CFP. 2212x1659. 45° FOV
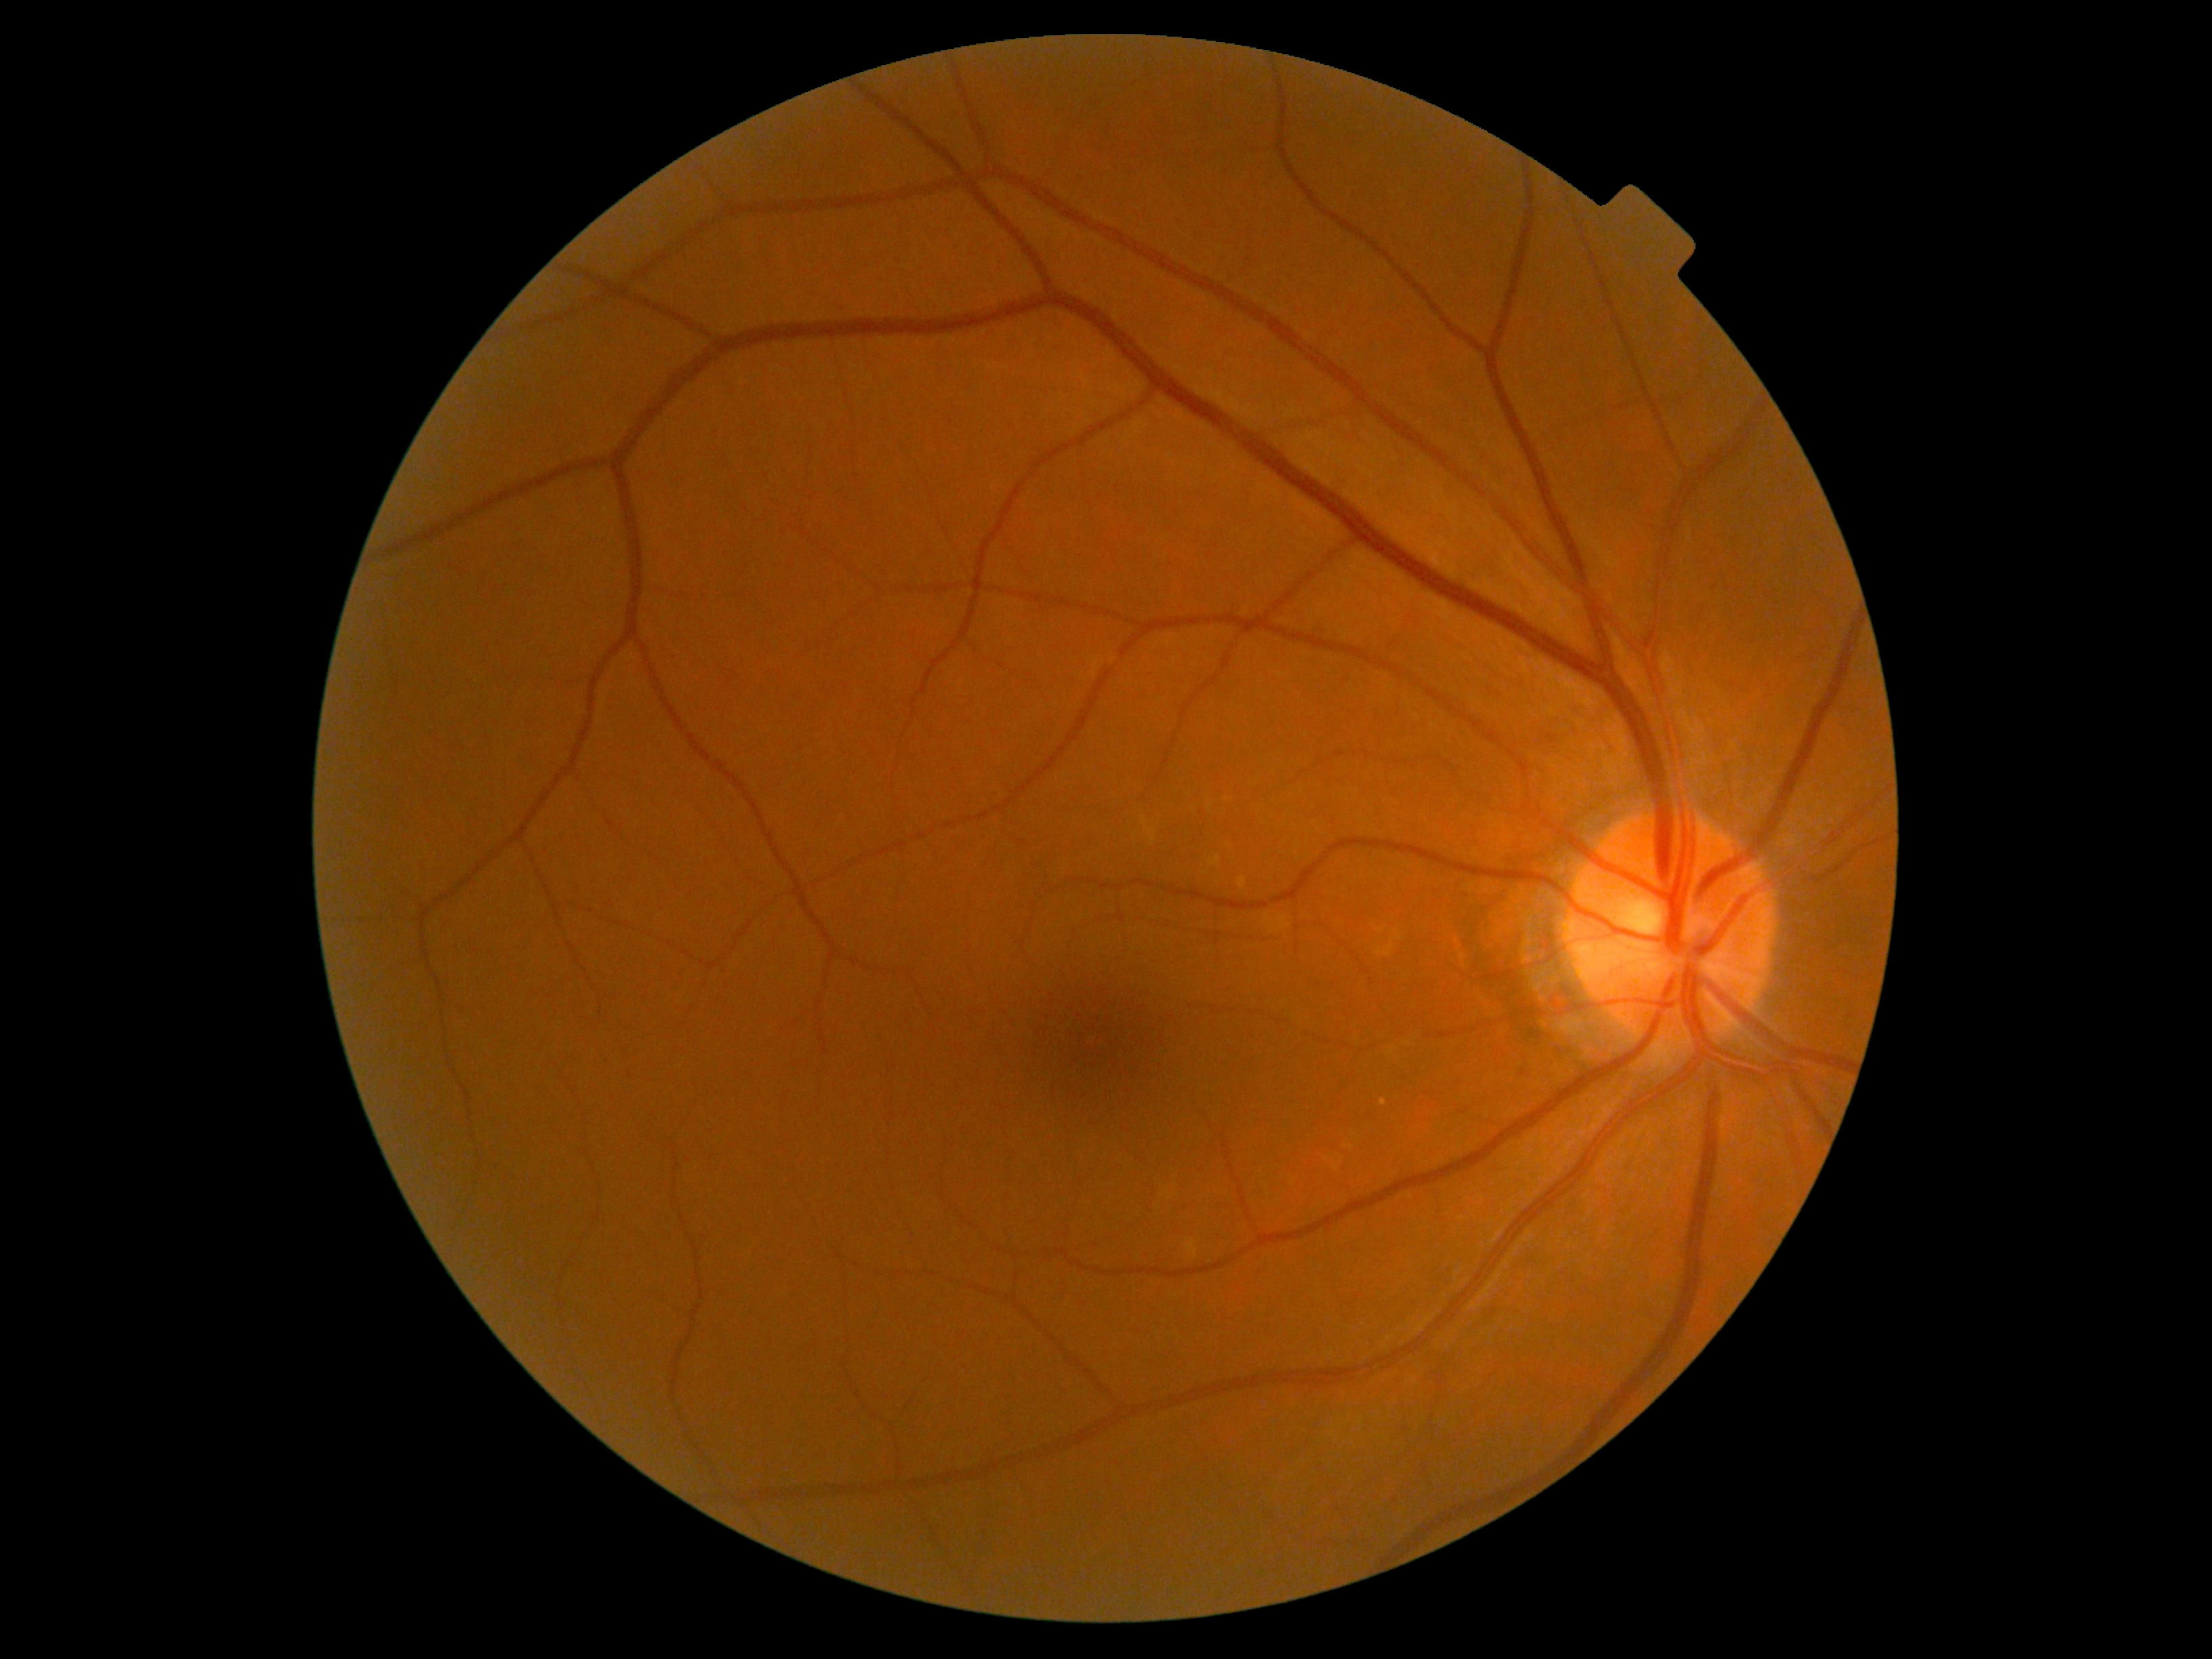 Diabetic retinopathy (DR) is no apparent retinopathy (grade 0).
No signs of diabetic retinopathy.